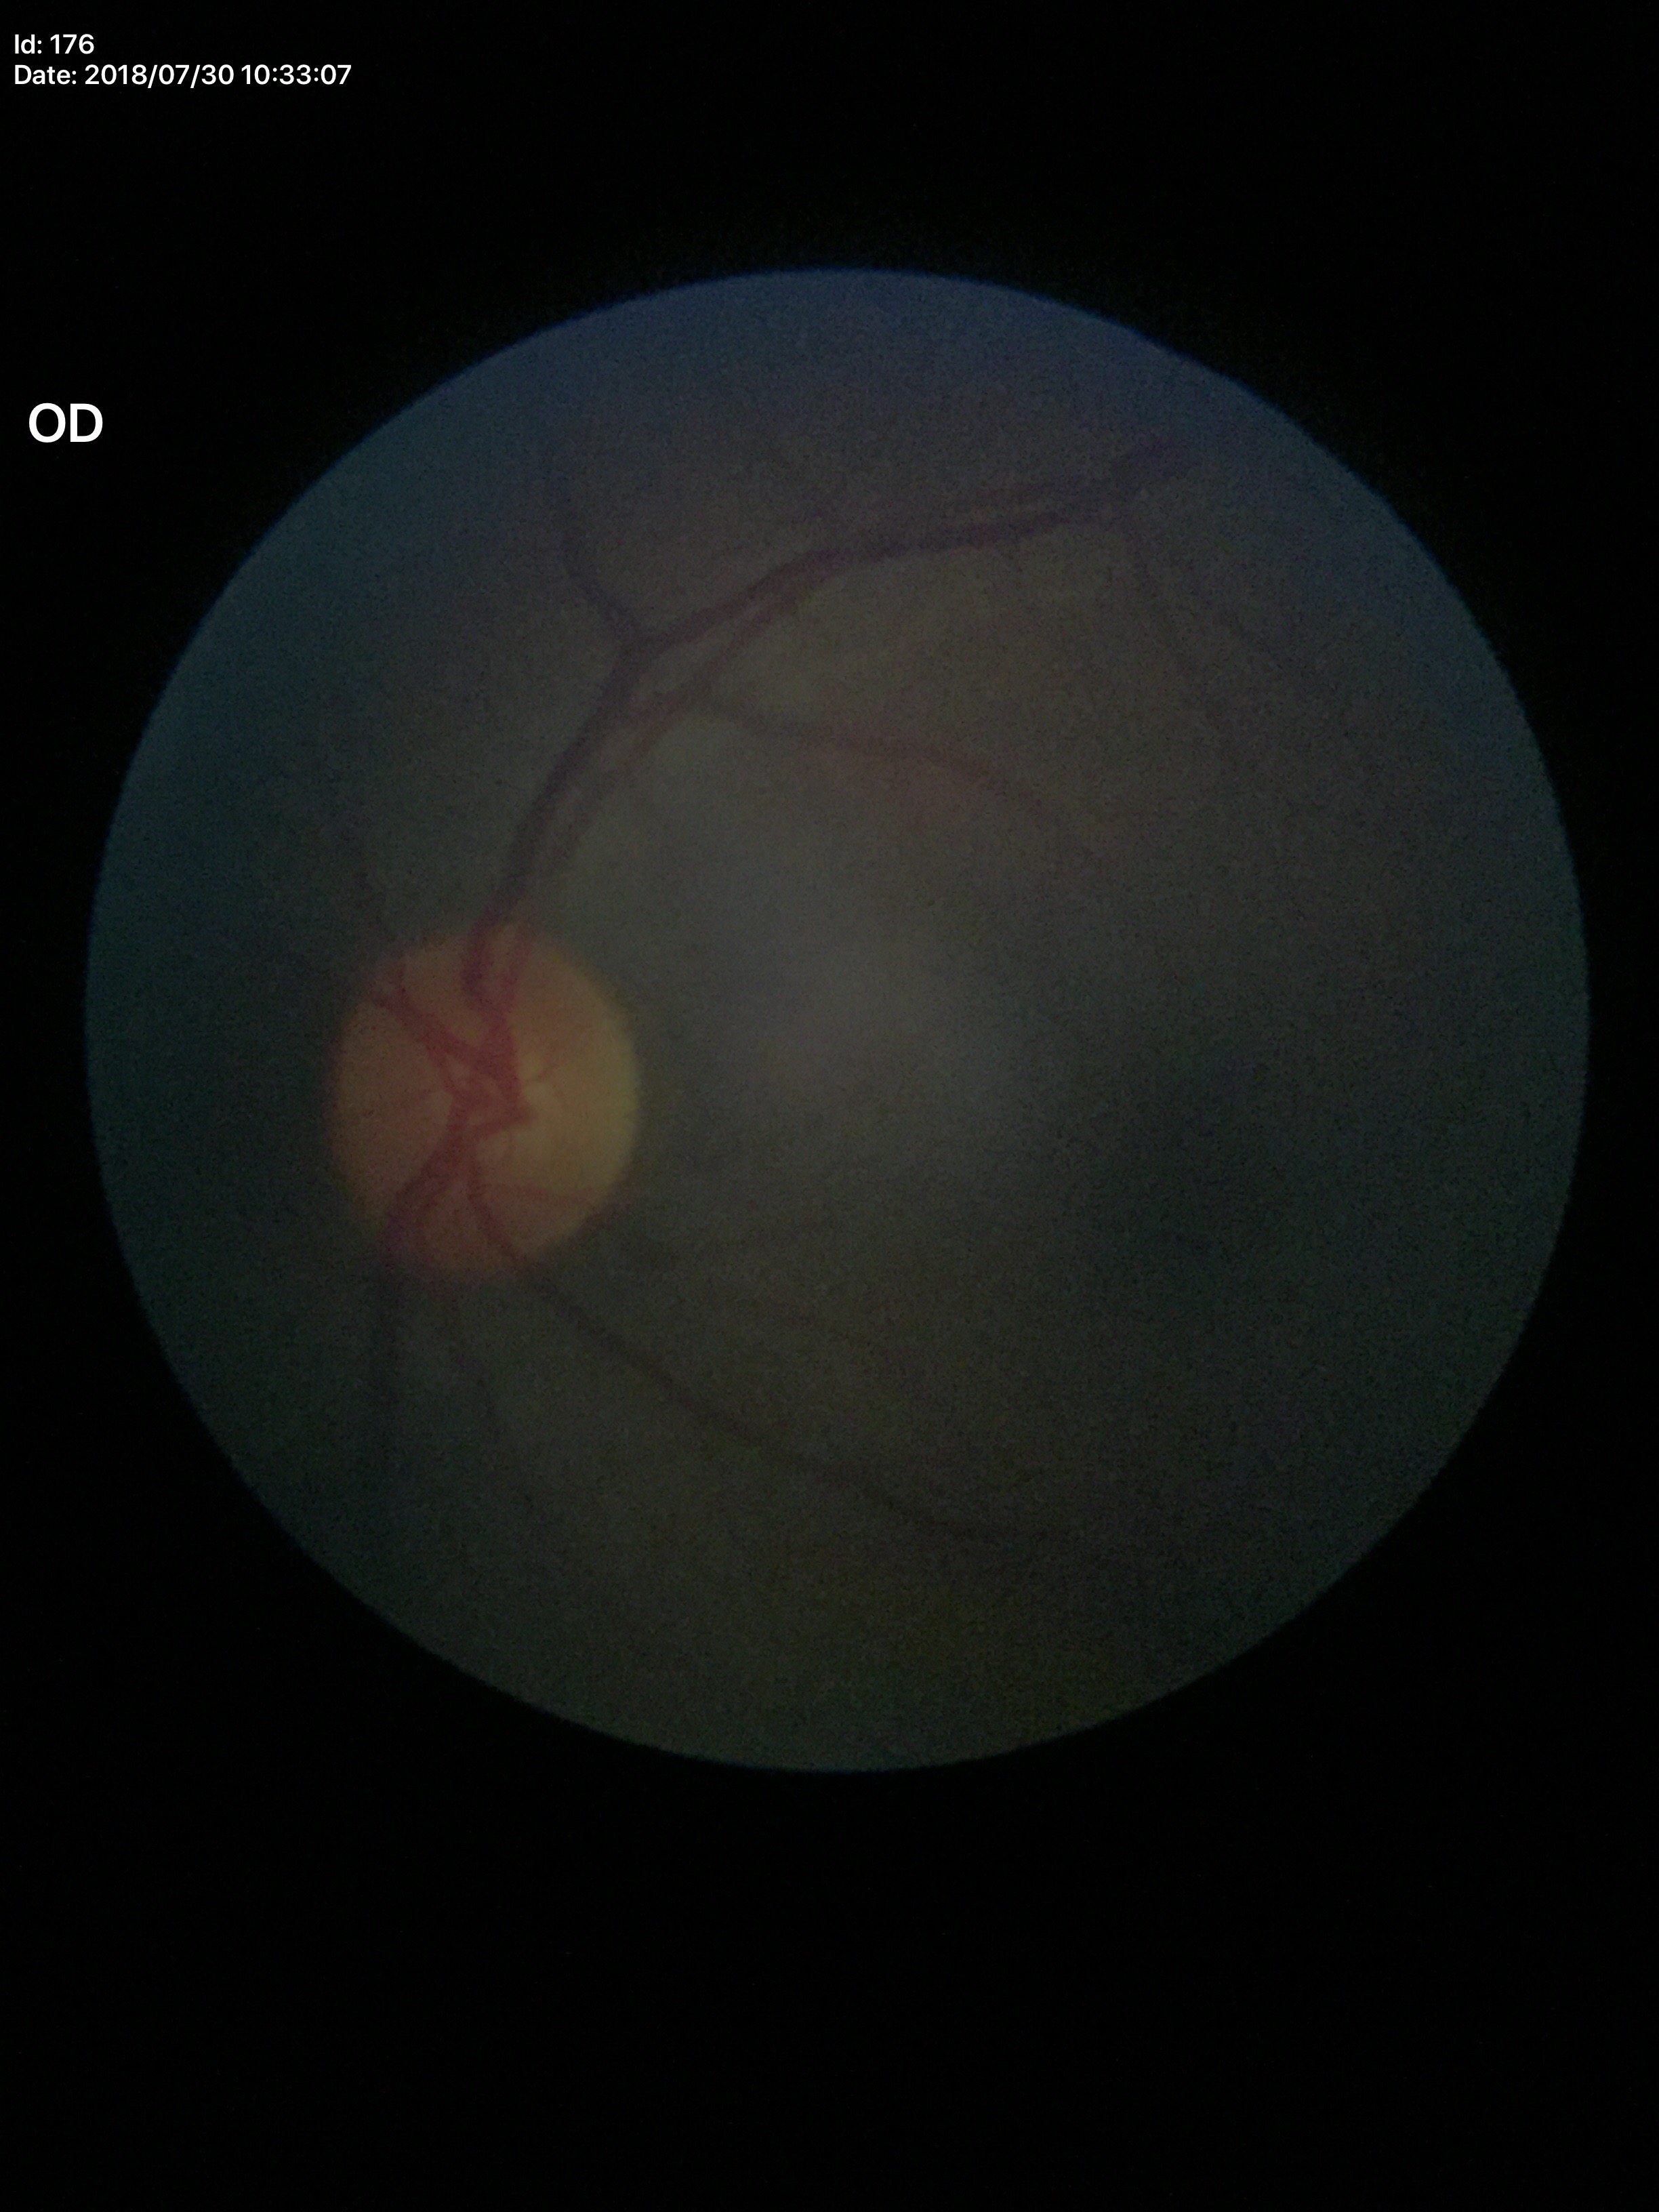
Not suspicious for glaucoma.
Vertical cup-disc ratio is 0.47.
Horizontal cup-to-disc ratio: 0.44.